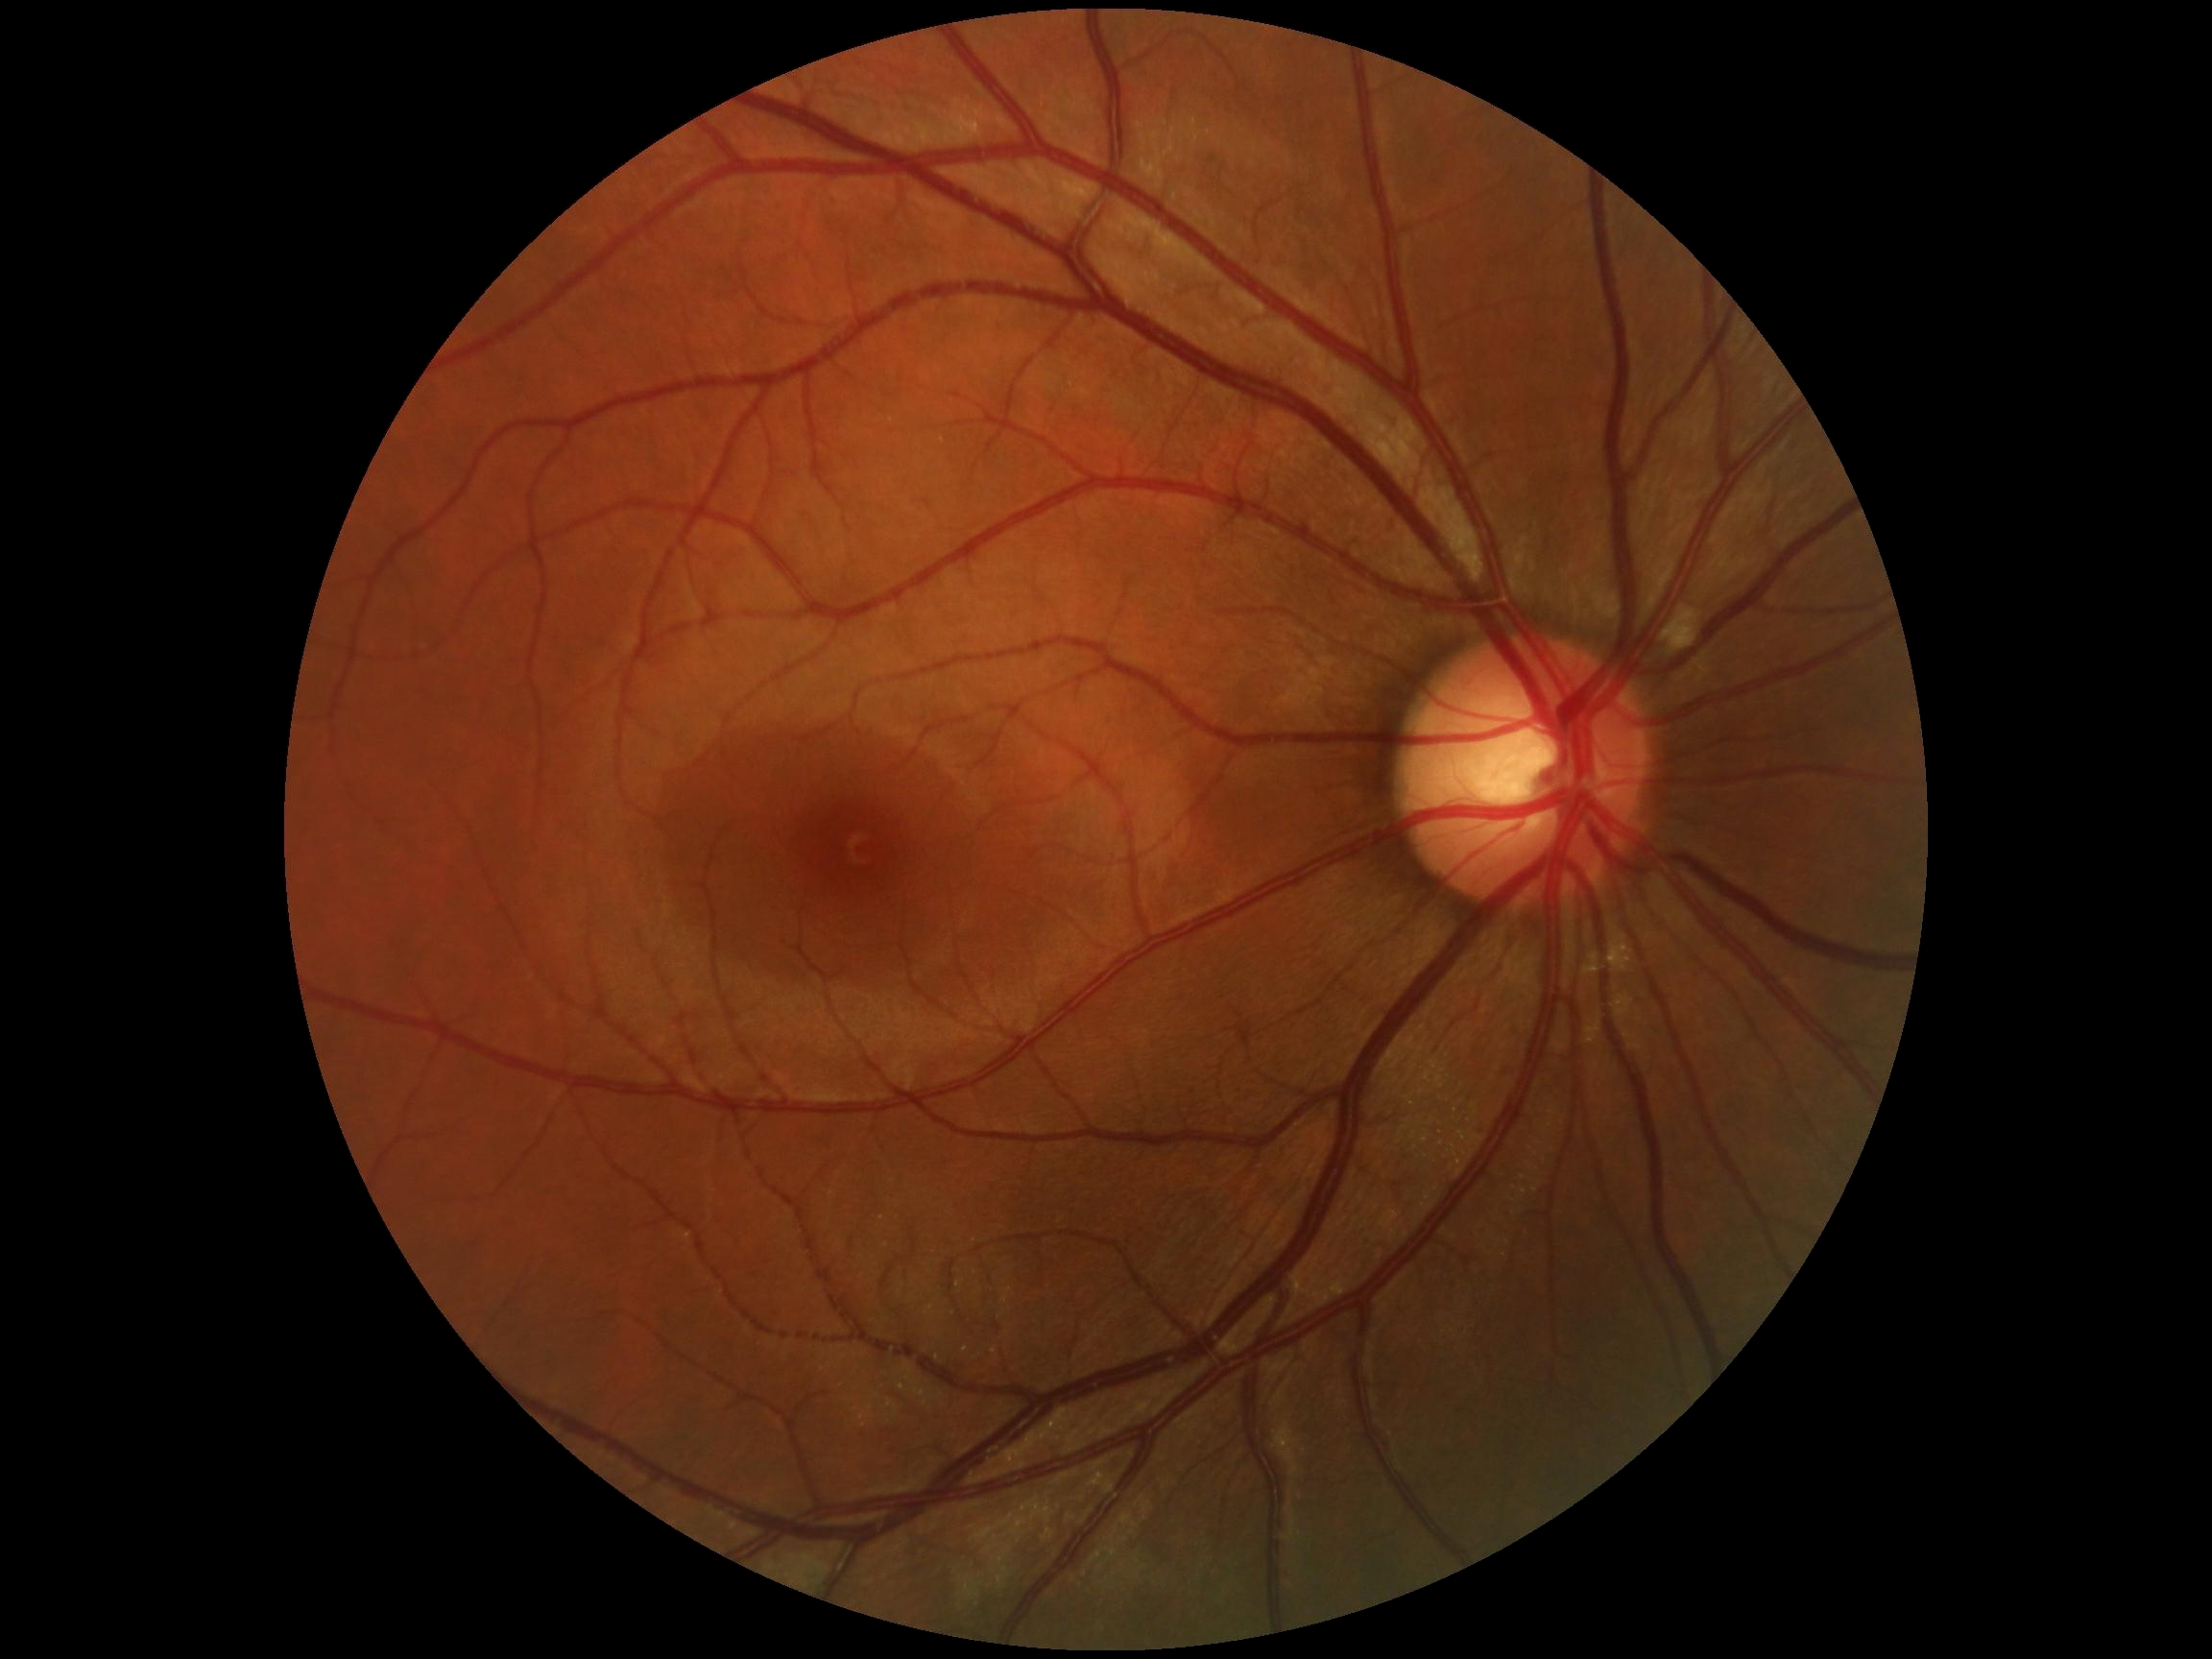
Retinopathy grade is 2 (moderate NPDR). DR class: non-proliferative diabetic retinopathy.